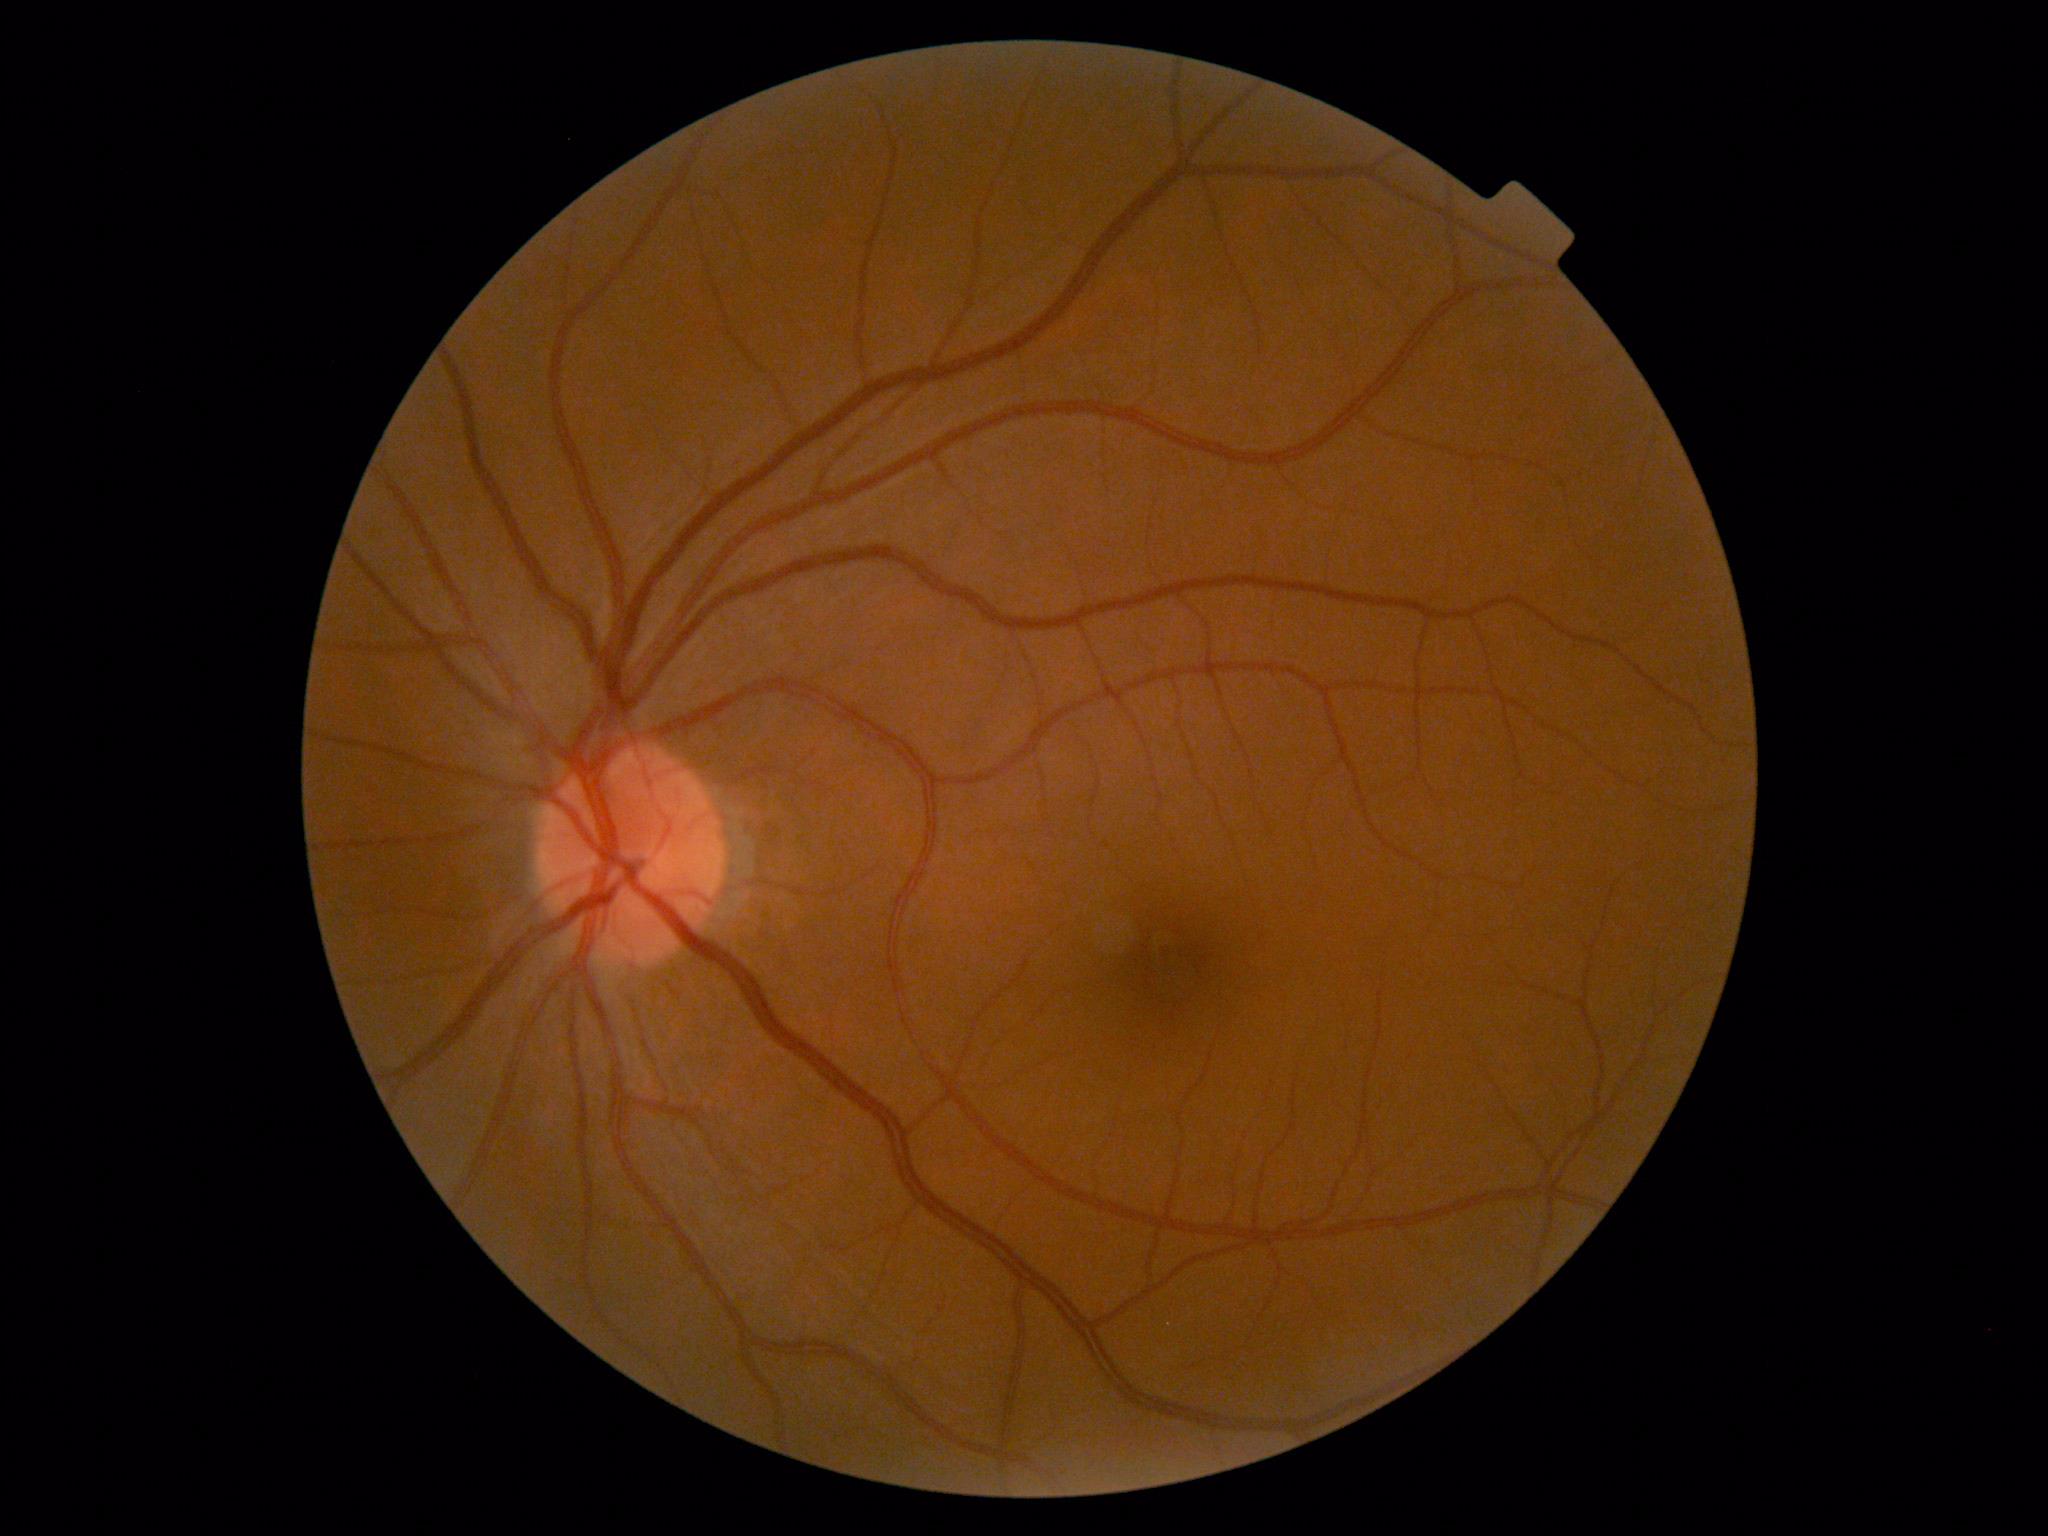

Diabetic retinopathy severity: grade 0 (no apparent retinopathy).